Graded on the modified Davis scale; color fundus image:
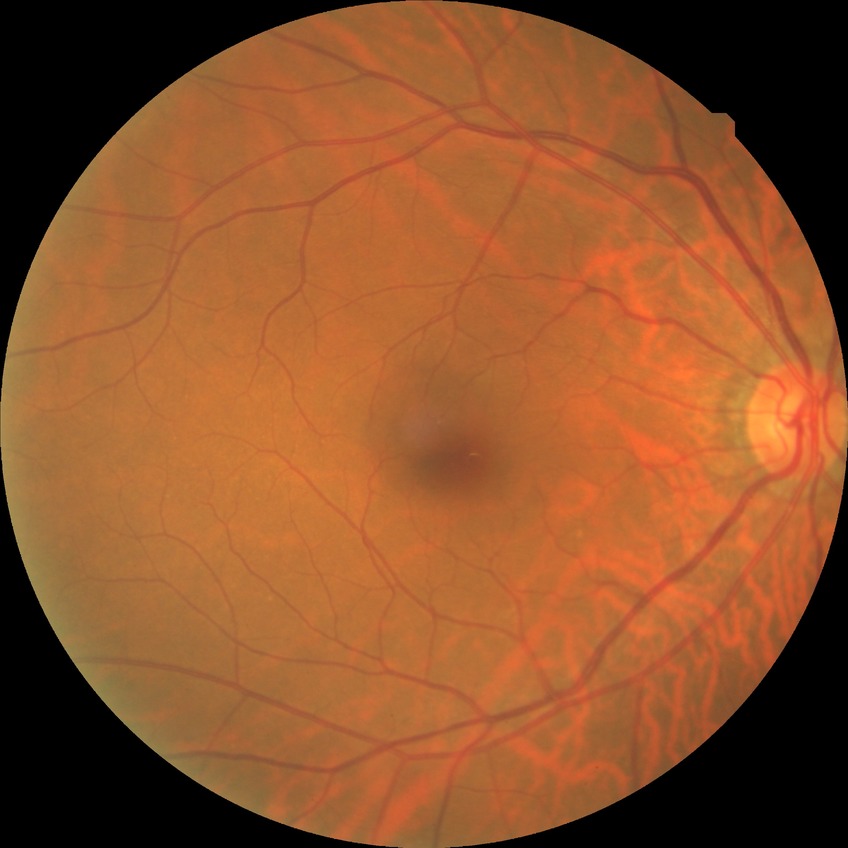

Diabetic retinopathy (DR) is no diabetic retinopathy (NDR).